Posterior pole photograph · 45° field of view:
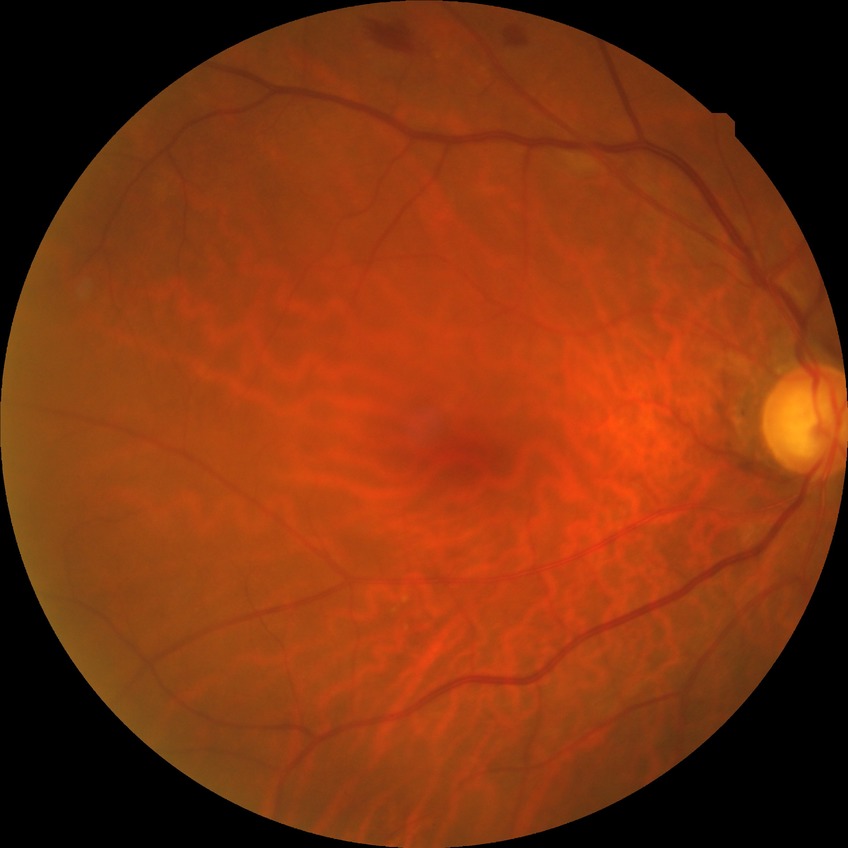

Assessment:
* diabetic retinopathy (DR): simple diabetic retinopathy (SDR)